50° field of view, color fundus image — 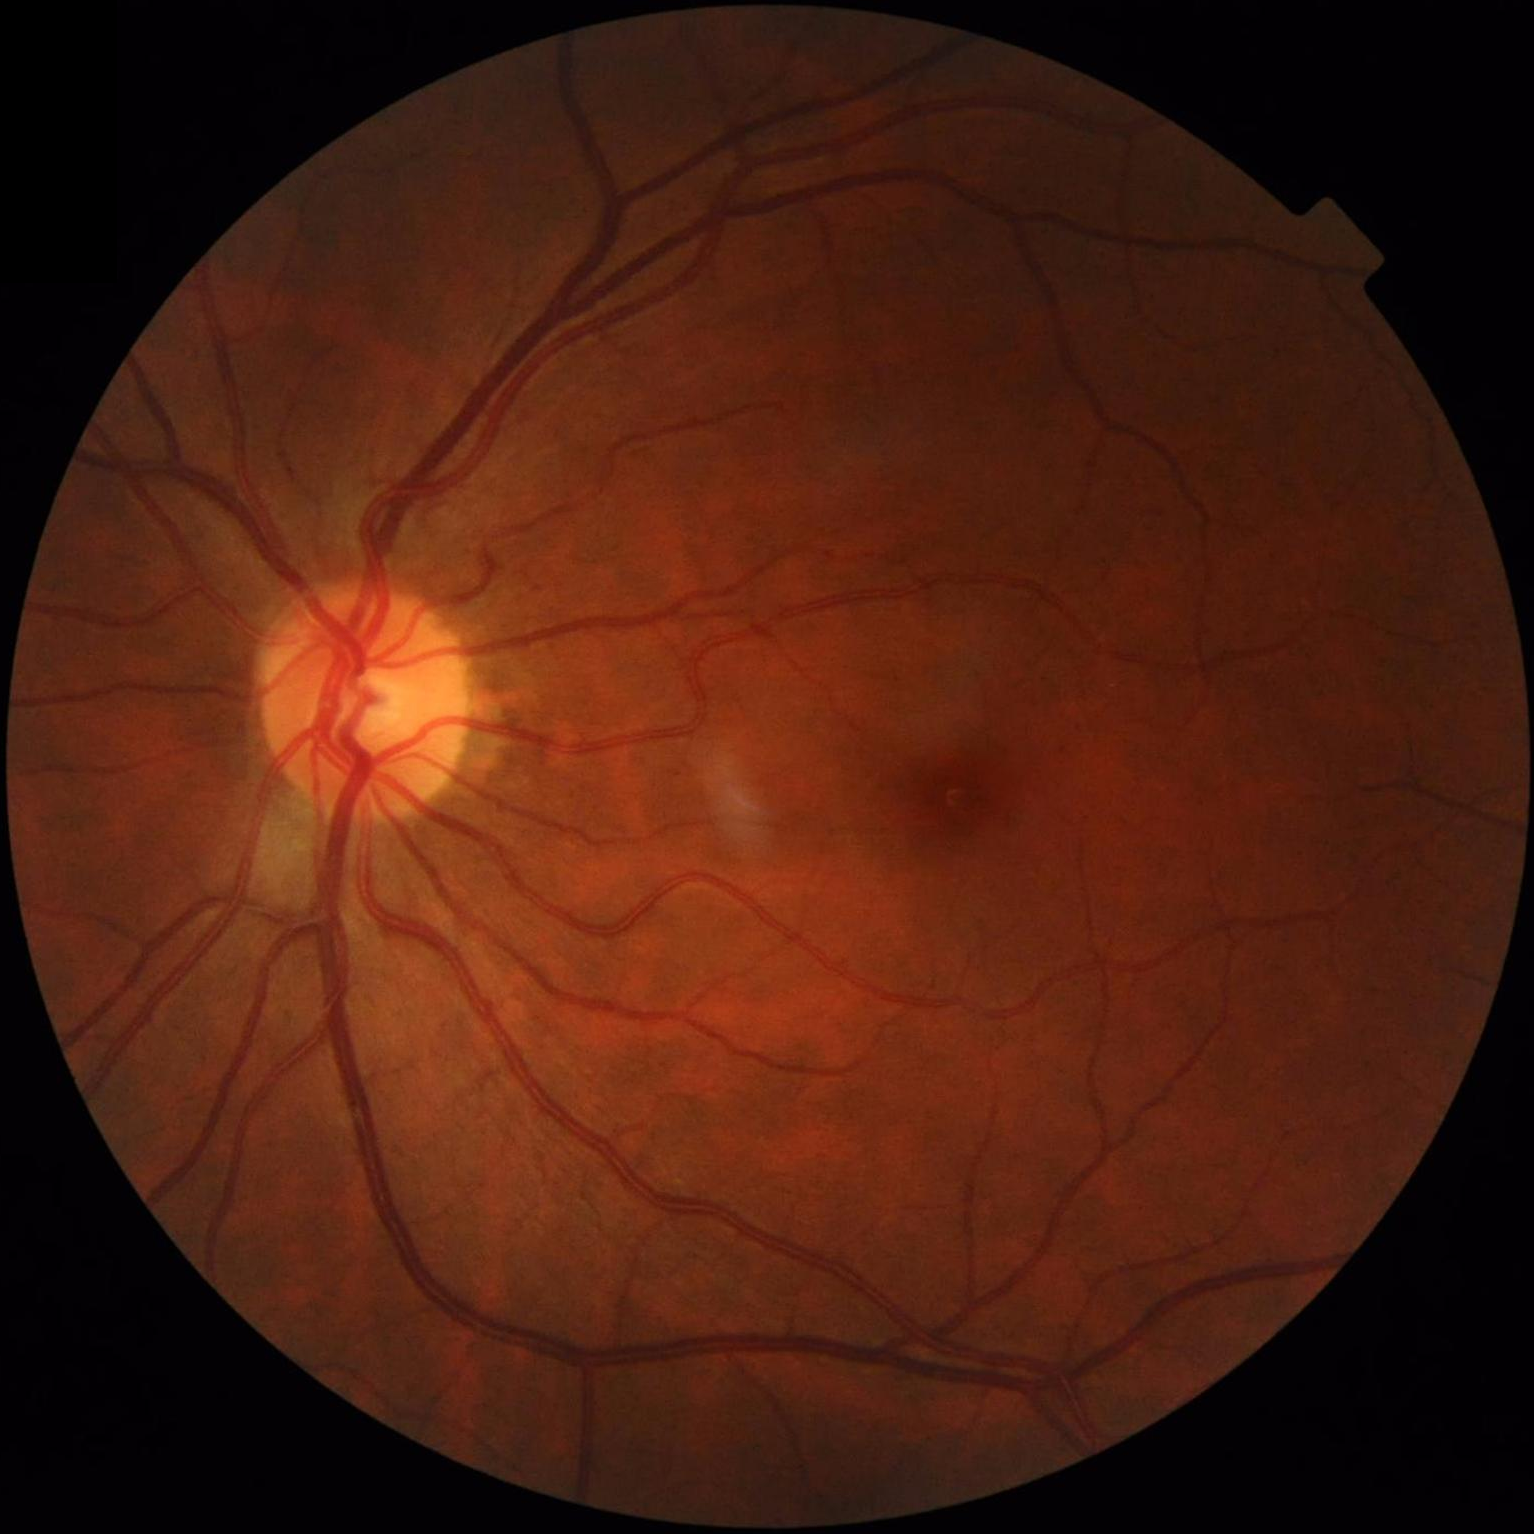
The image is clear.
Acceptable image quality.
Vessels and details are readily distinguishable.
Illumination and color balance are good.